45-degree field of view, color fundus image.
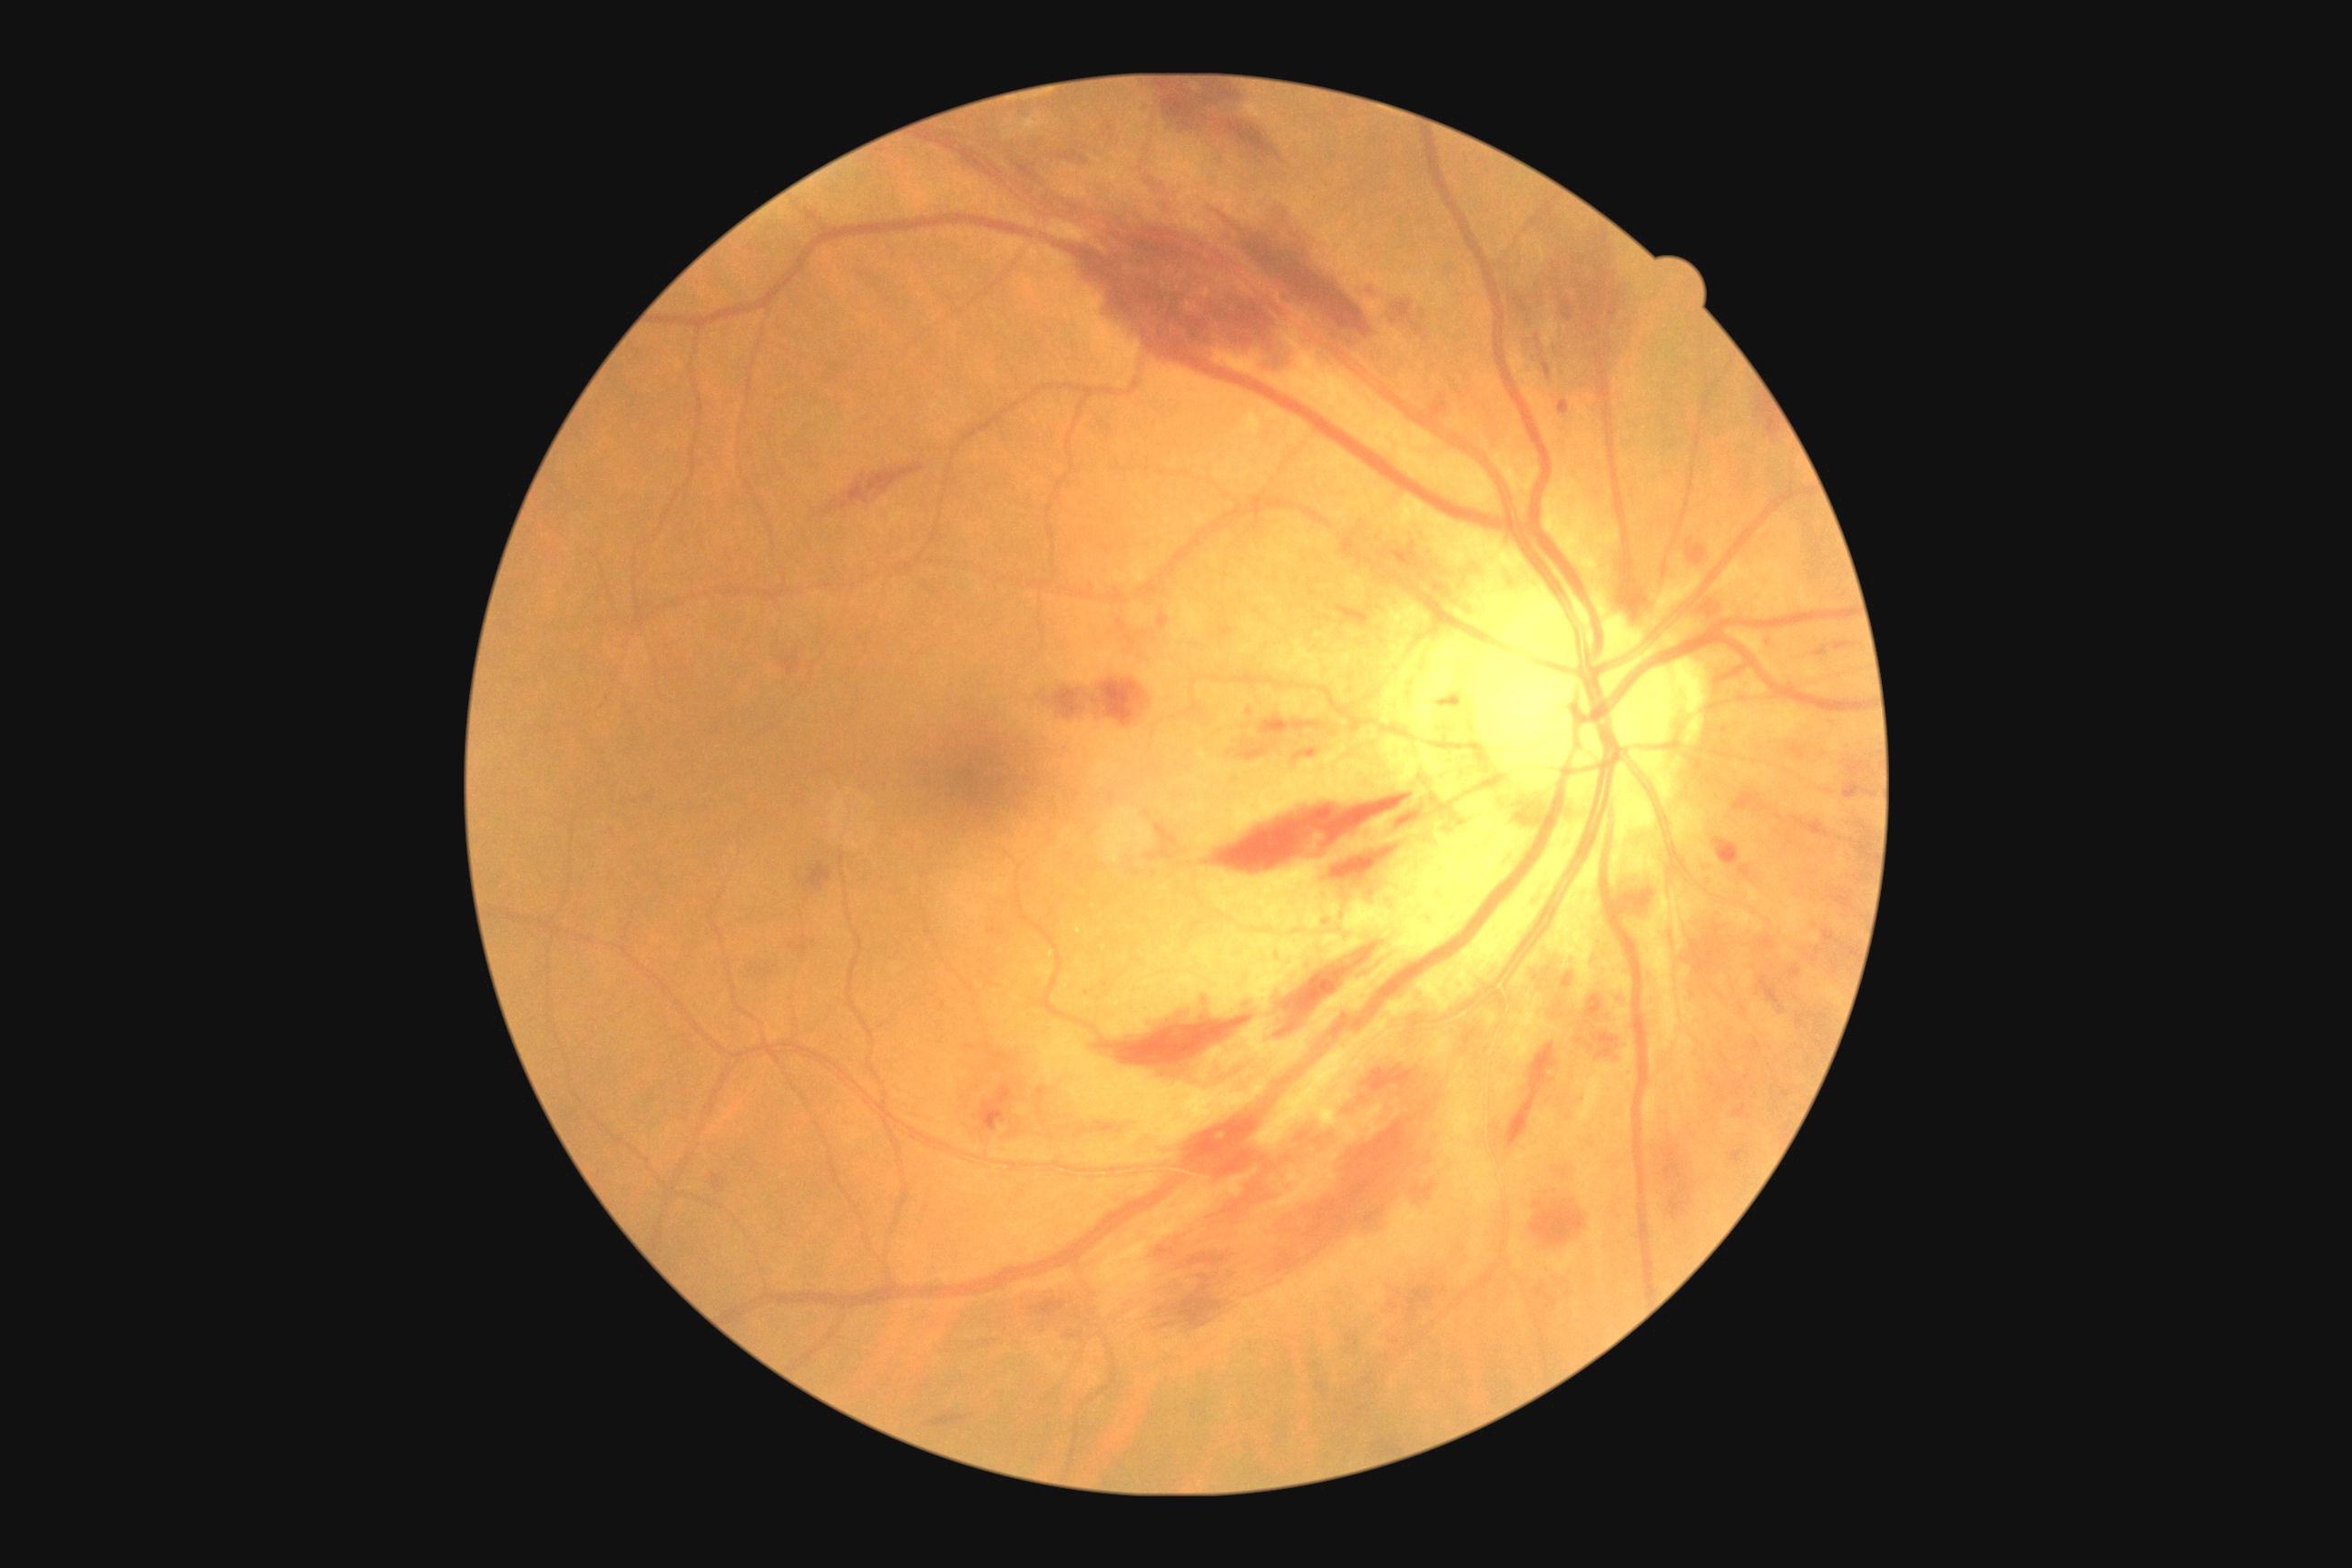 {"partial":true,"dr_grade":2,"dr_grade_name":"moderate NPDR","lesions":{"he":[[1298,750,1315,760],[1792,818,1832,838],[1843,783,1876,799],[823,464,925,516],[1754,1041,1761,1052],[1054,689,1086,718],[1393,807,1431,825],[1812,647,1828,658],[1102,124,1121,137],[1364,1066,1415,1093],[1195,1113,1328,1224],[1531,1200,1585,1246],[1834,642,1857,652],[1092,1122,1115,1135],[1039,1300,1064,1317],[1687,540,1707,565]],"he_small":[[1348,1111]]}}